Acquired on the Phoenix ICON. Wide-field fundus photograph of an infant.
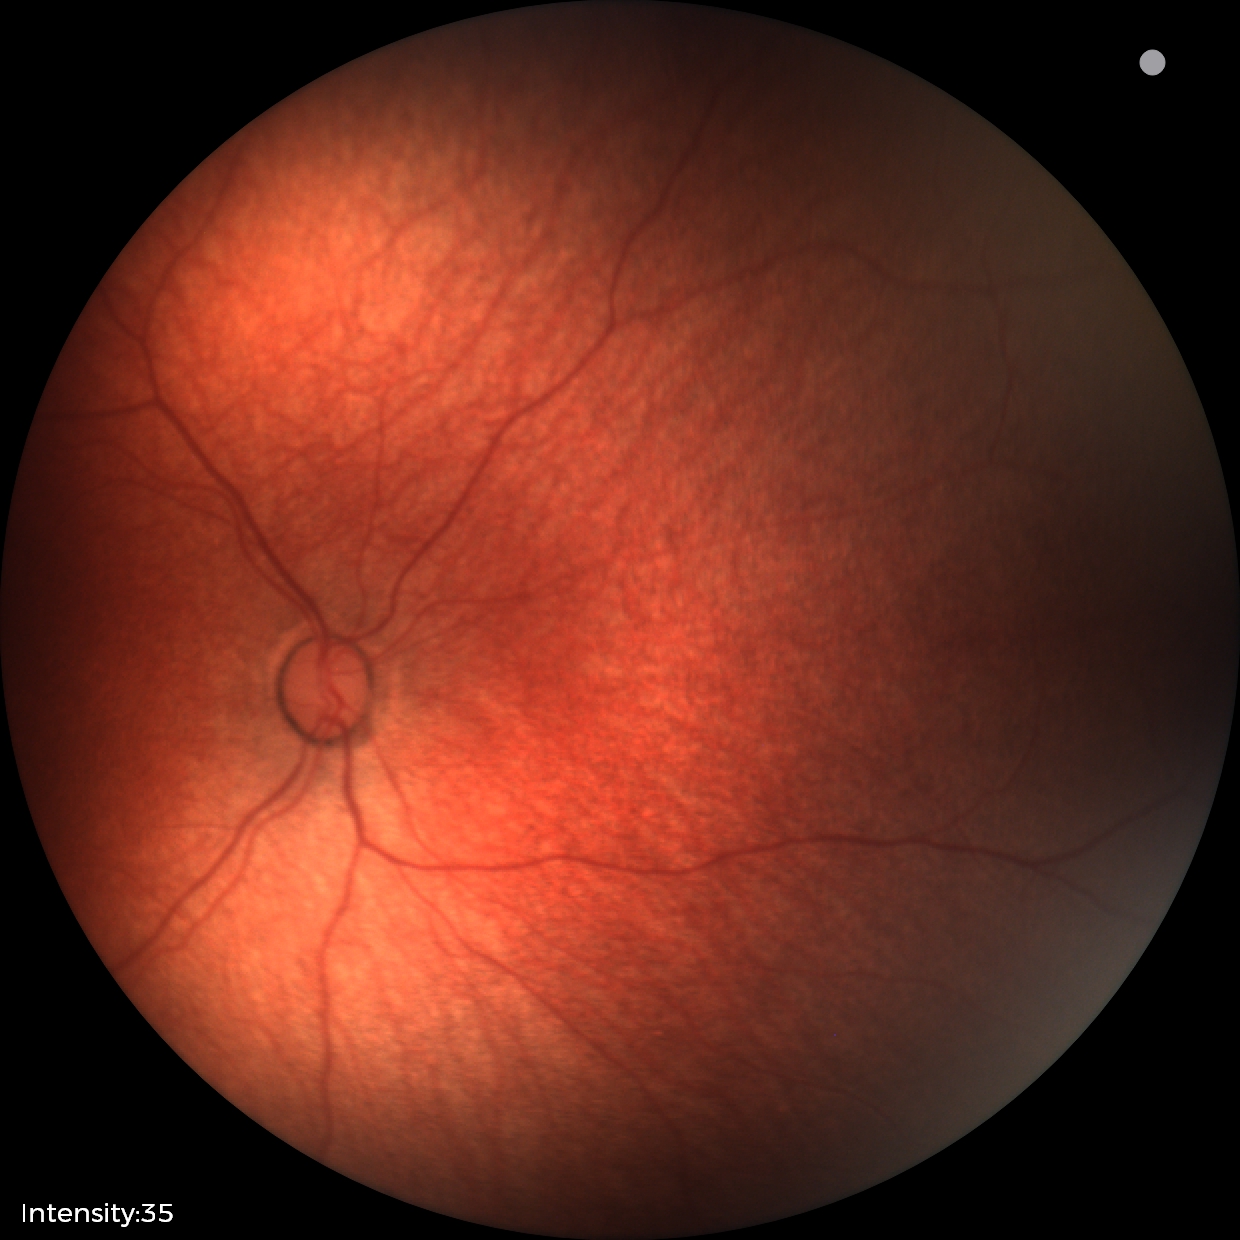

Screening diagnosis: physiological retinal finding.